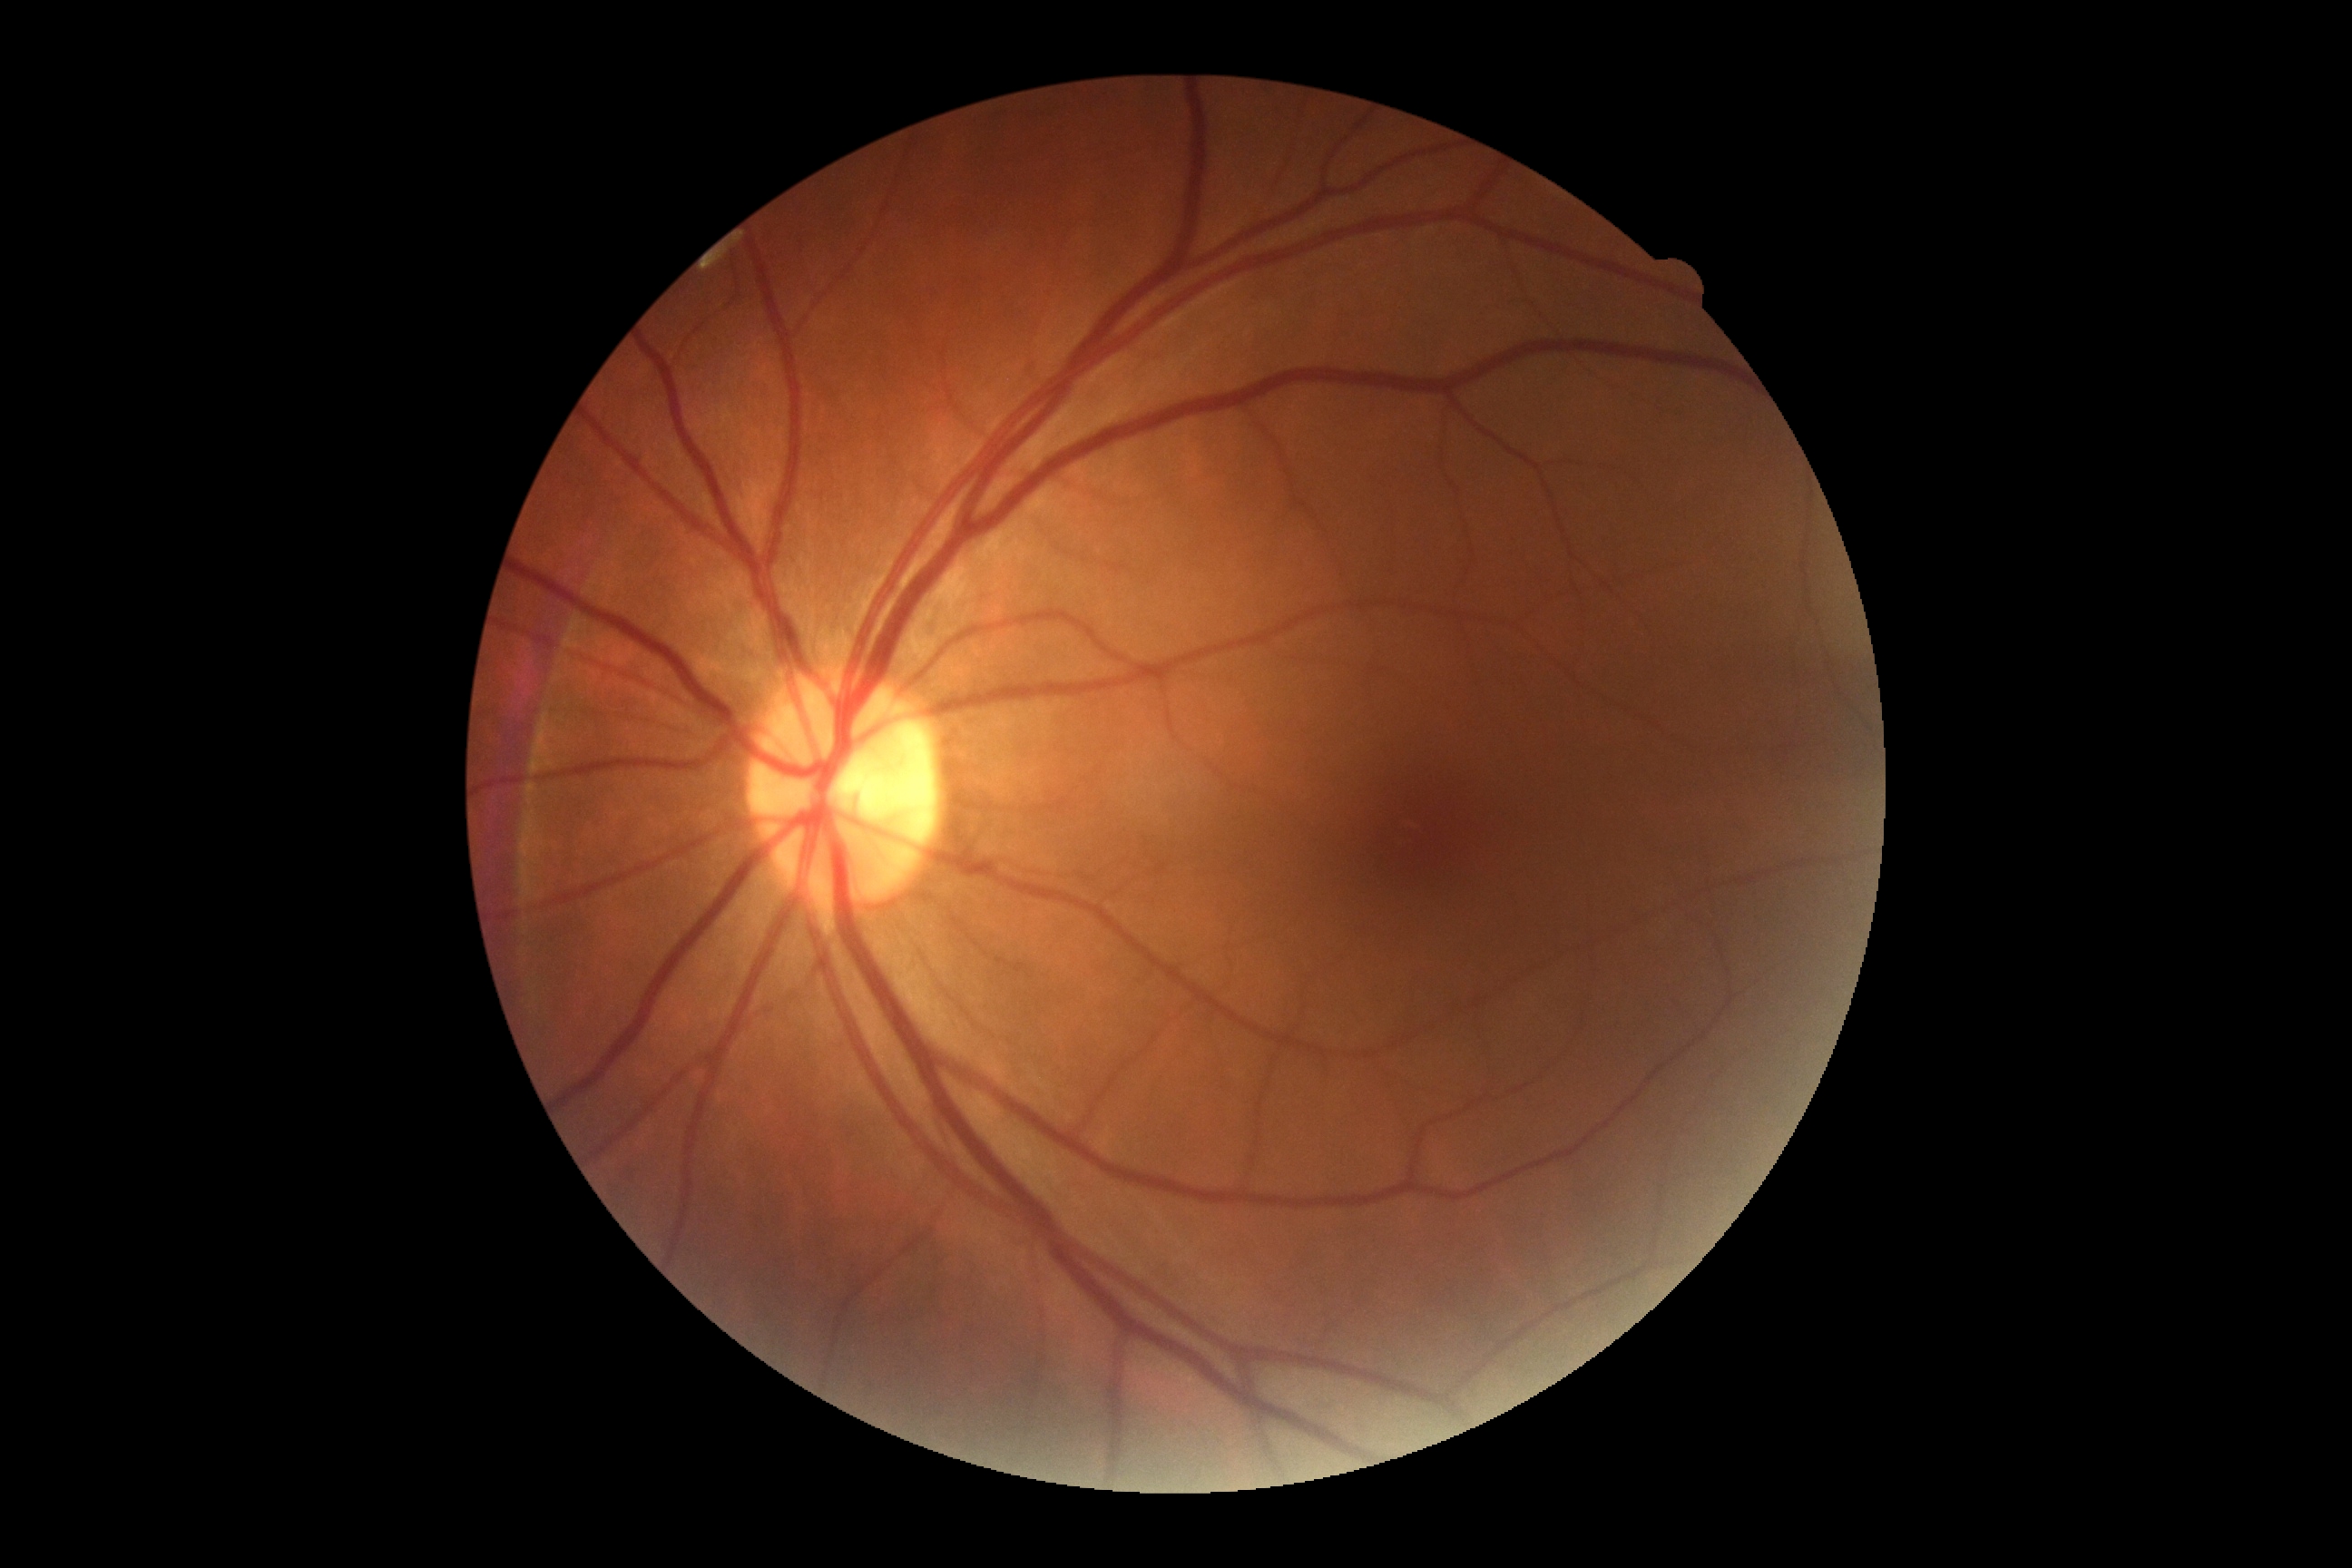
Retinopathy is no apparent retinopathy (grade 0).